2089x1764px. Color fundus image — 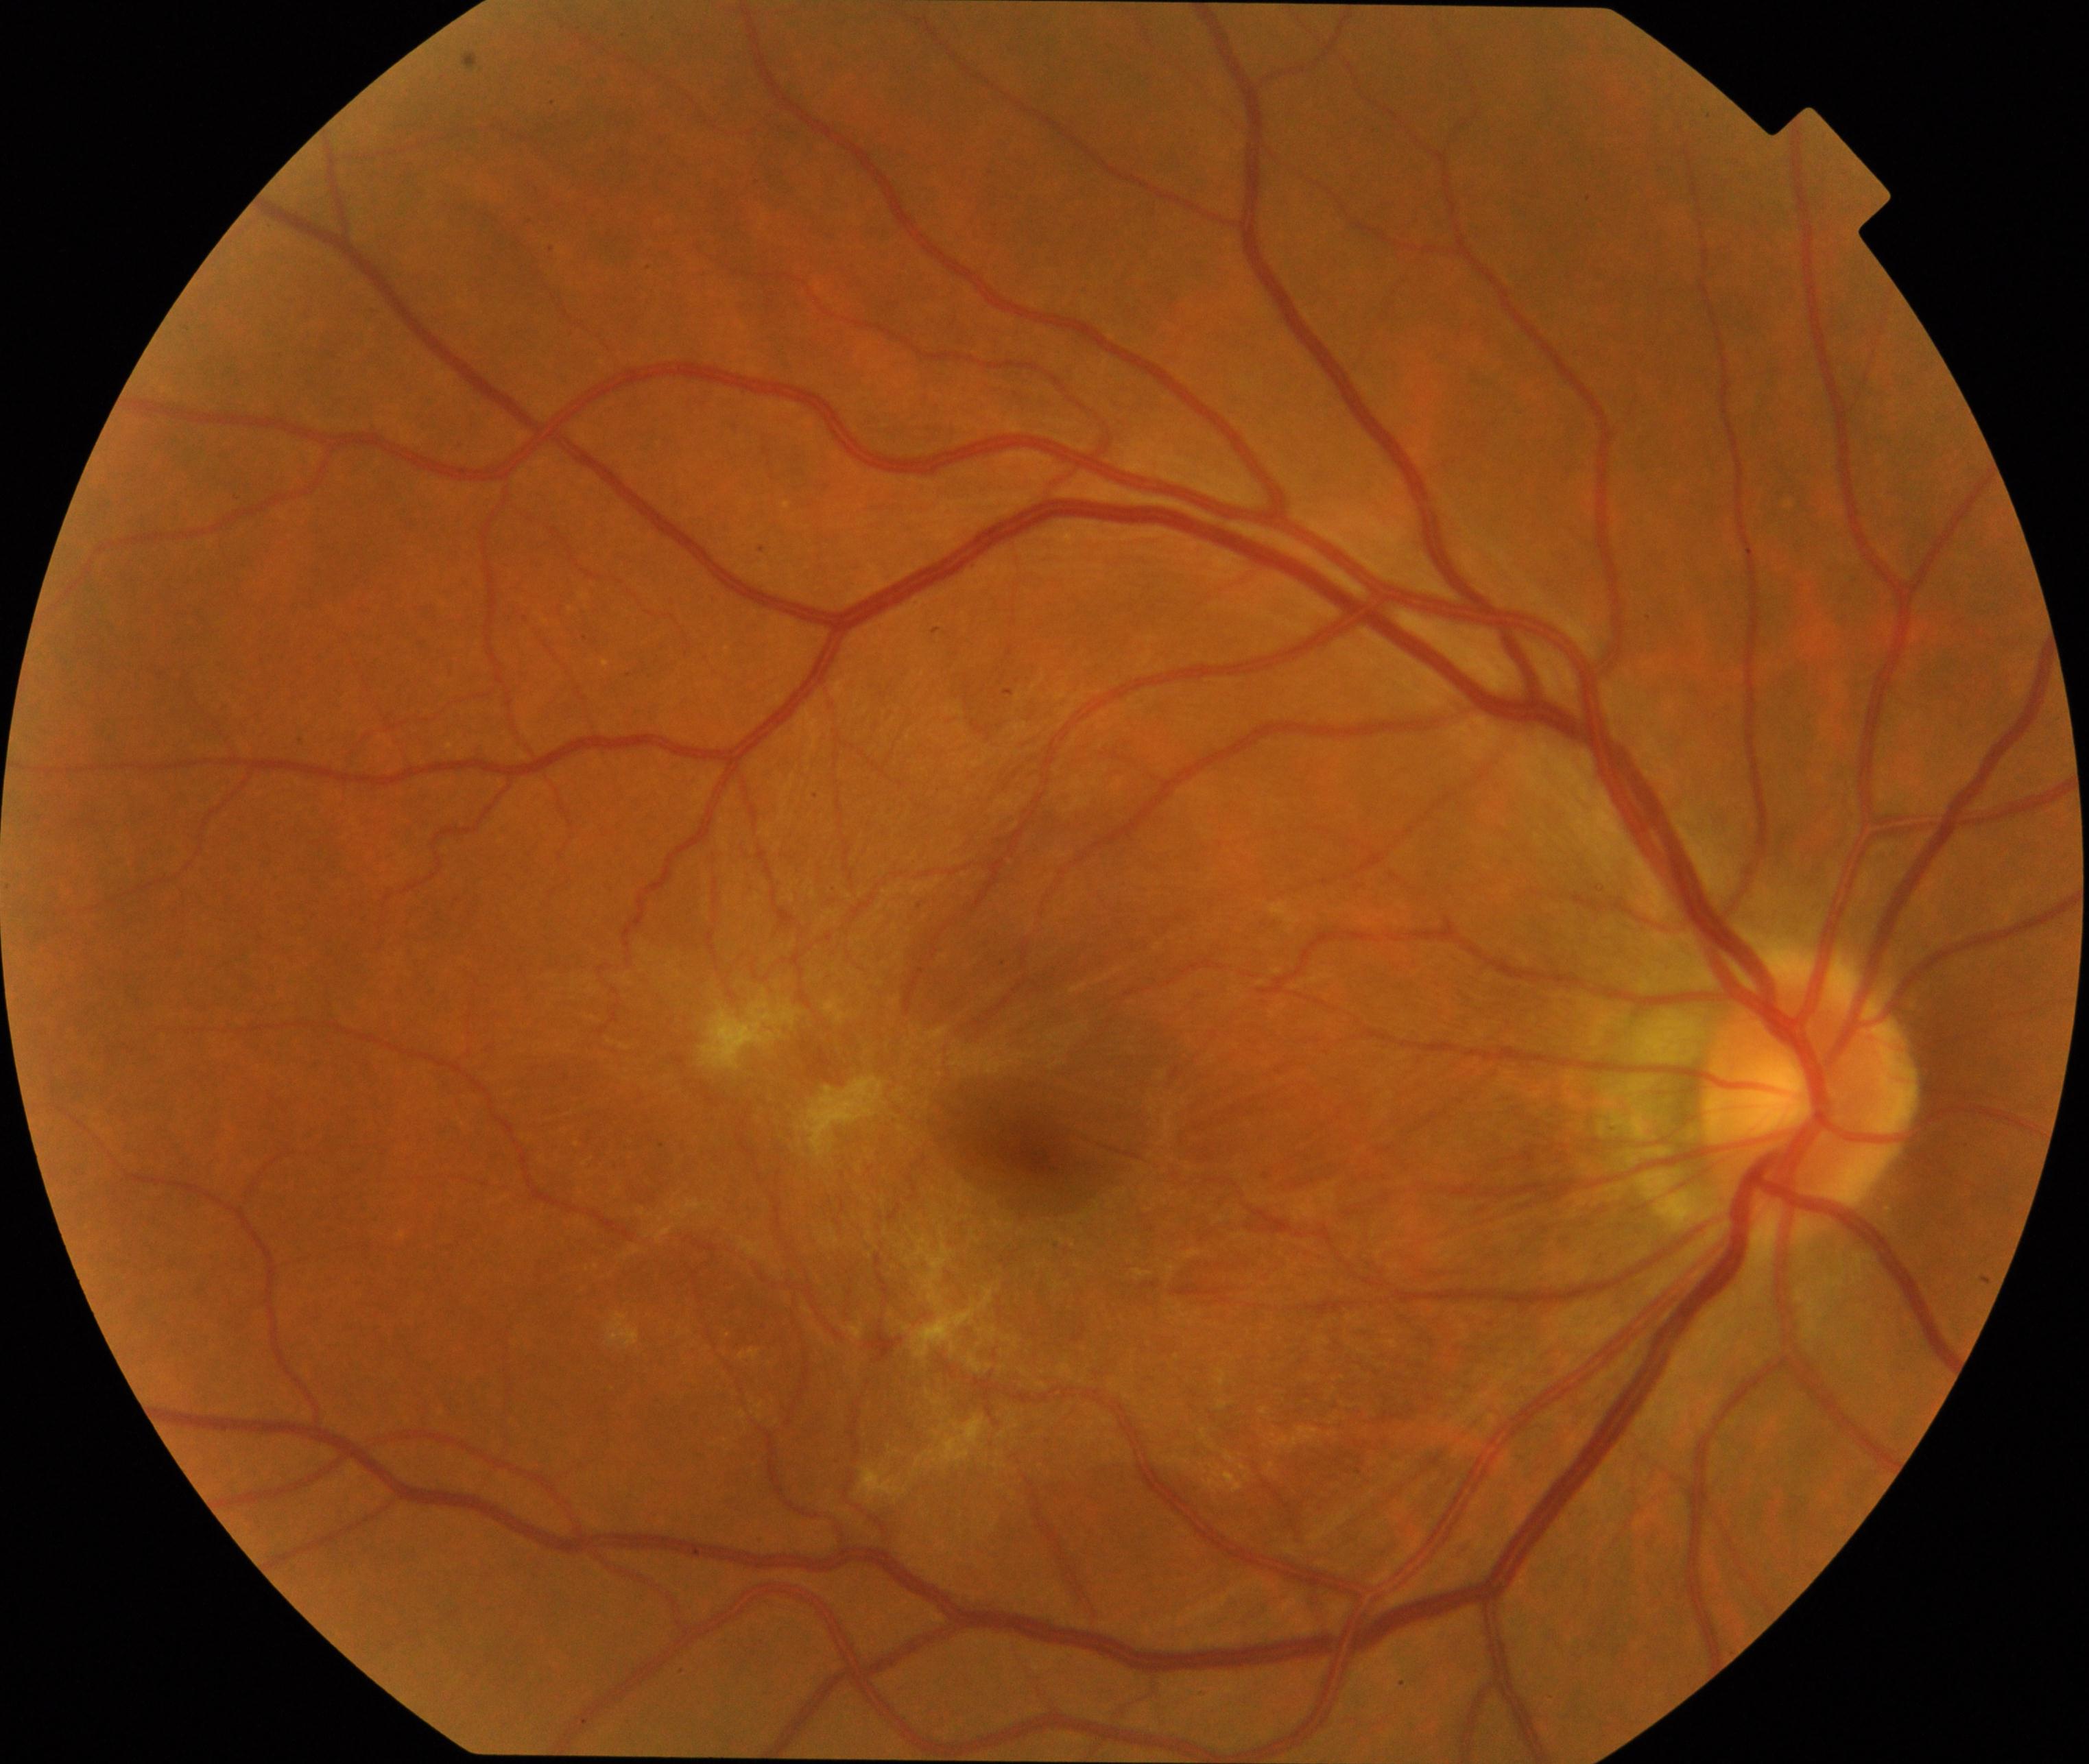
Consistent with epiretinal membrane.